Image size 2346x1568, fundus photo, FOV: 45 degrees:
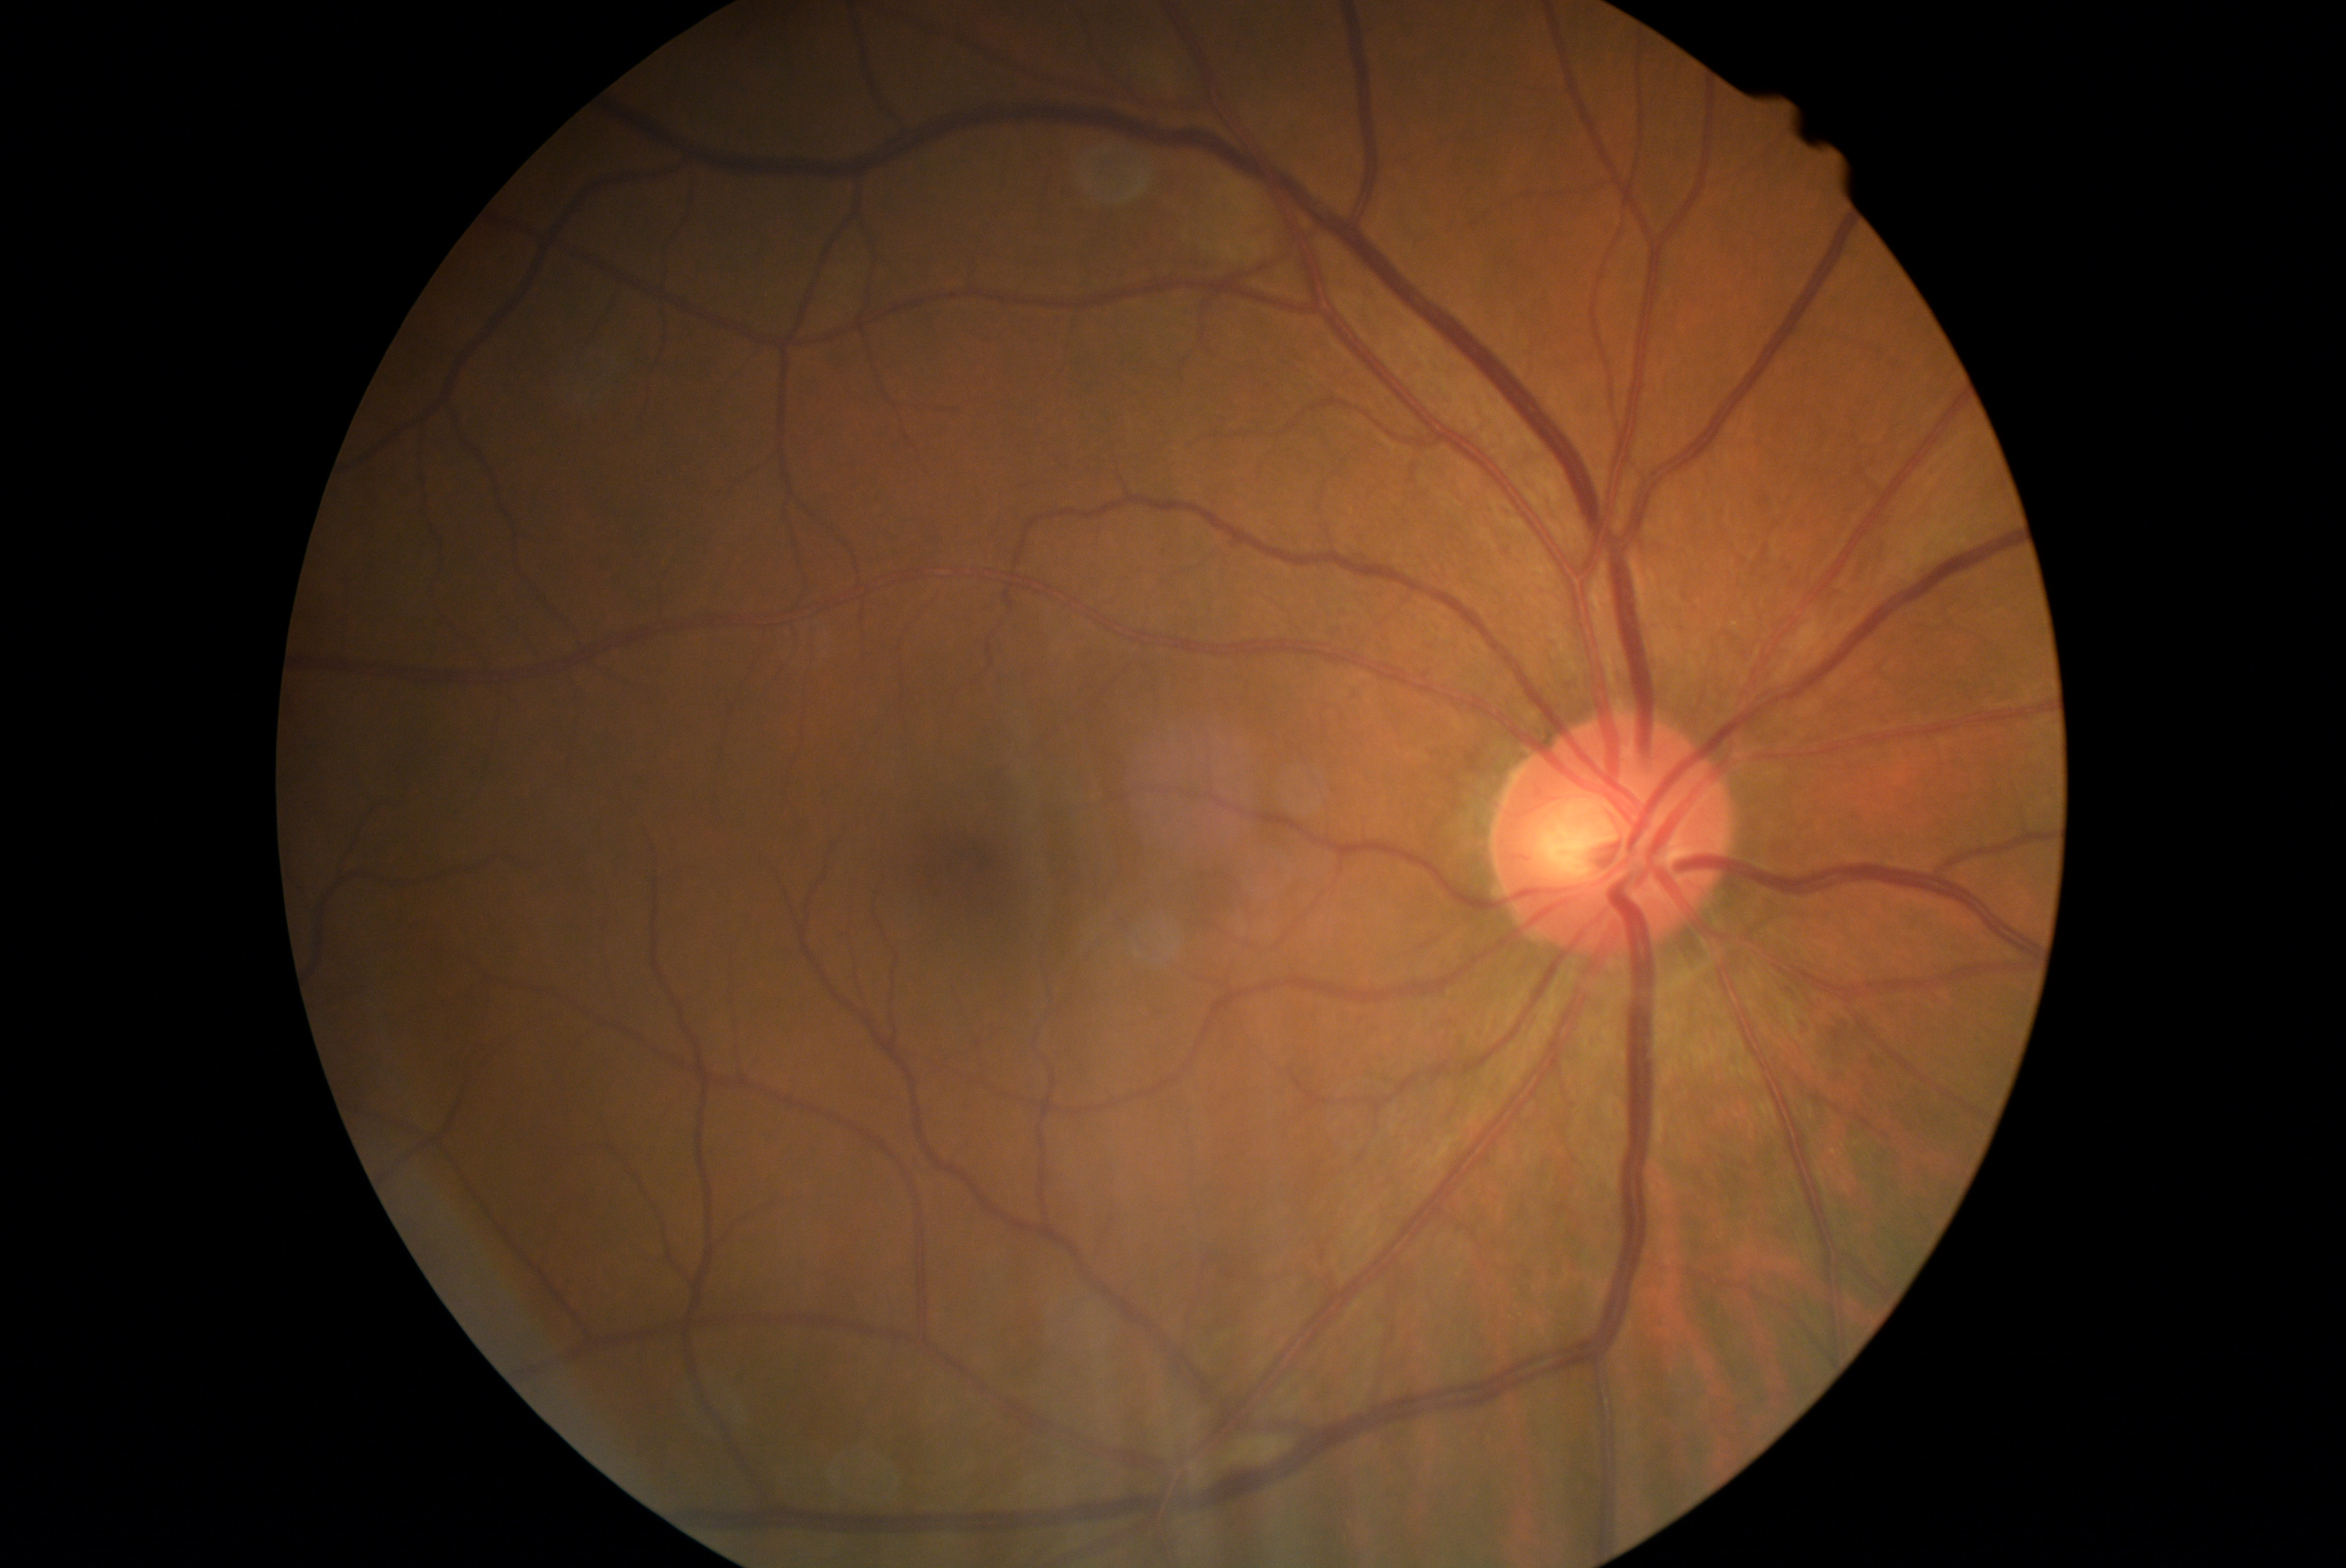
Diabetic retinopathy is 2/4 — more than just microaneurysms but less than severe NPDR.